Disc-centered field
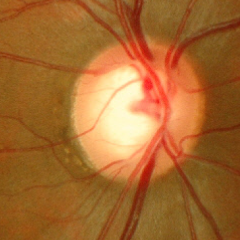
Early glaucomatous optic neuropathy.